Wide-field contact fundus photograph of an infant — 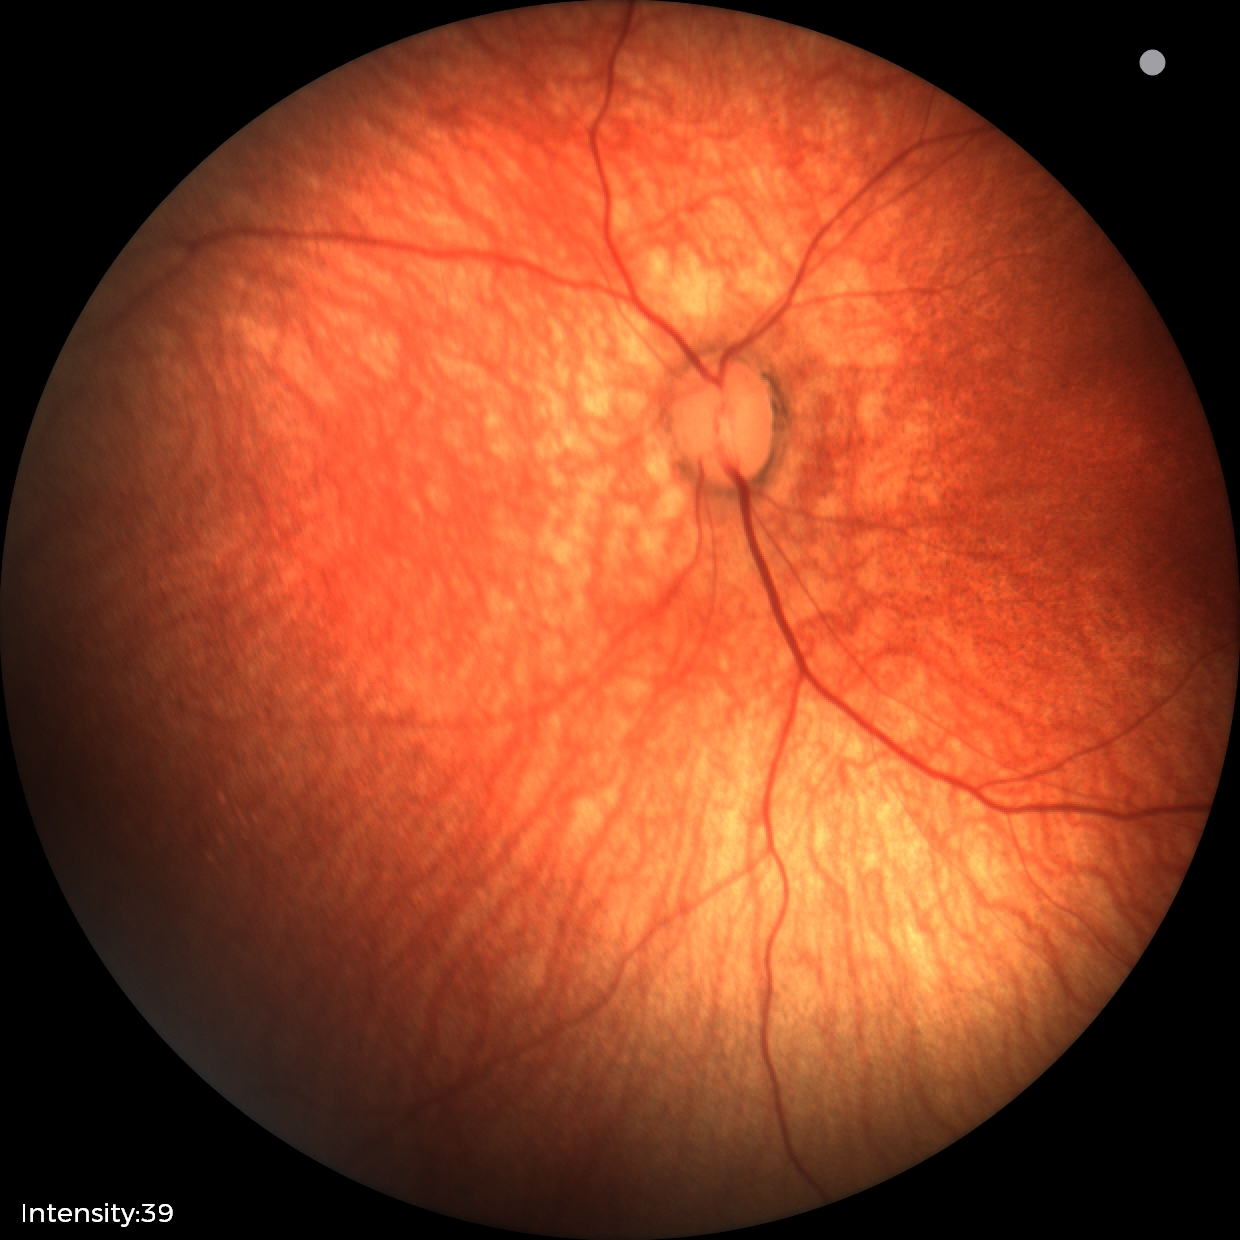

Physiological retinal appearance for postconceptual age.